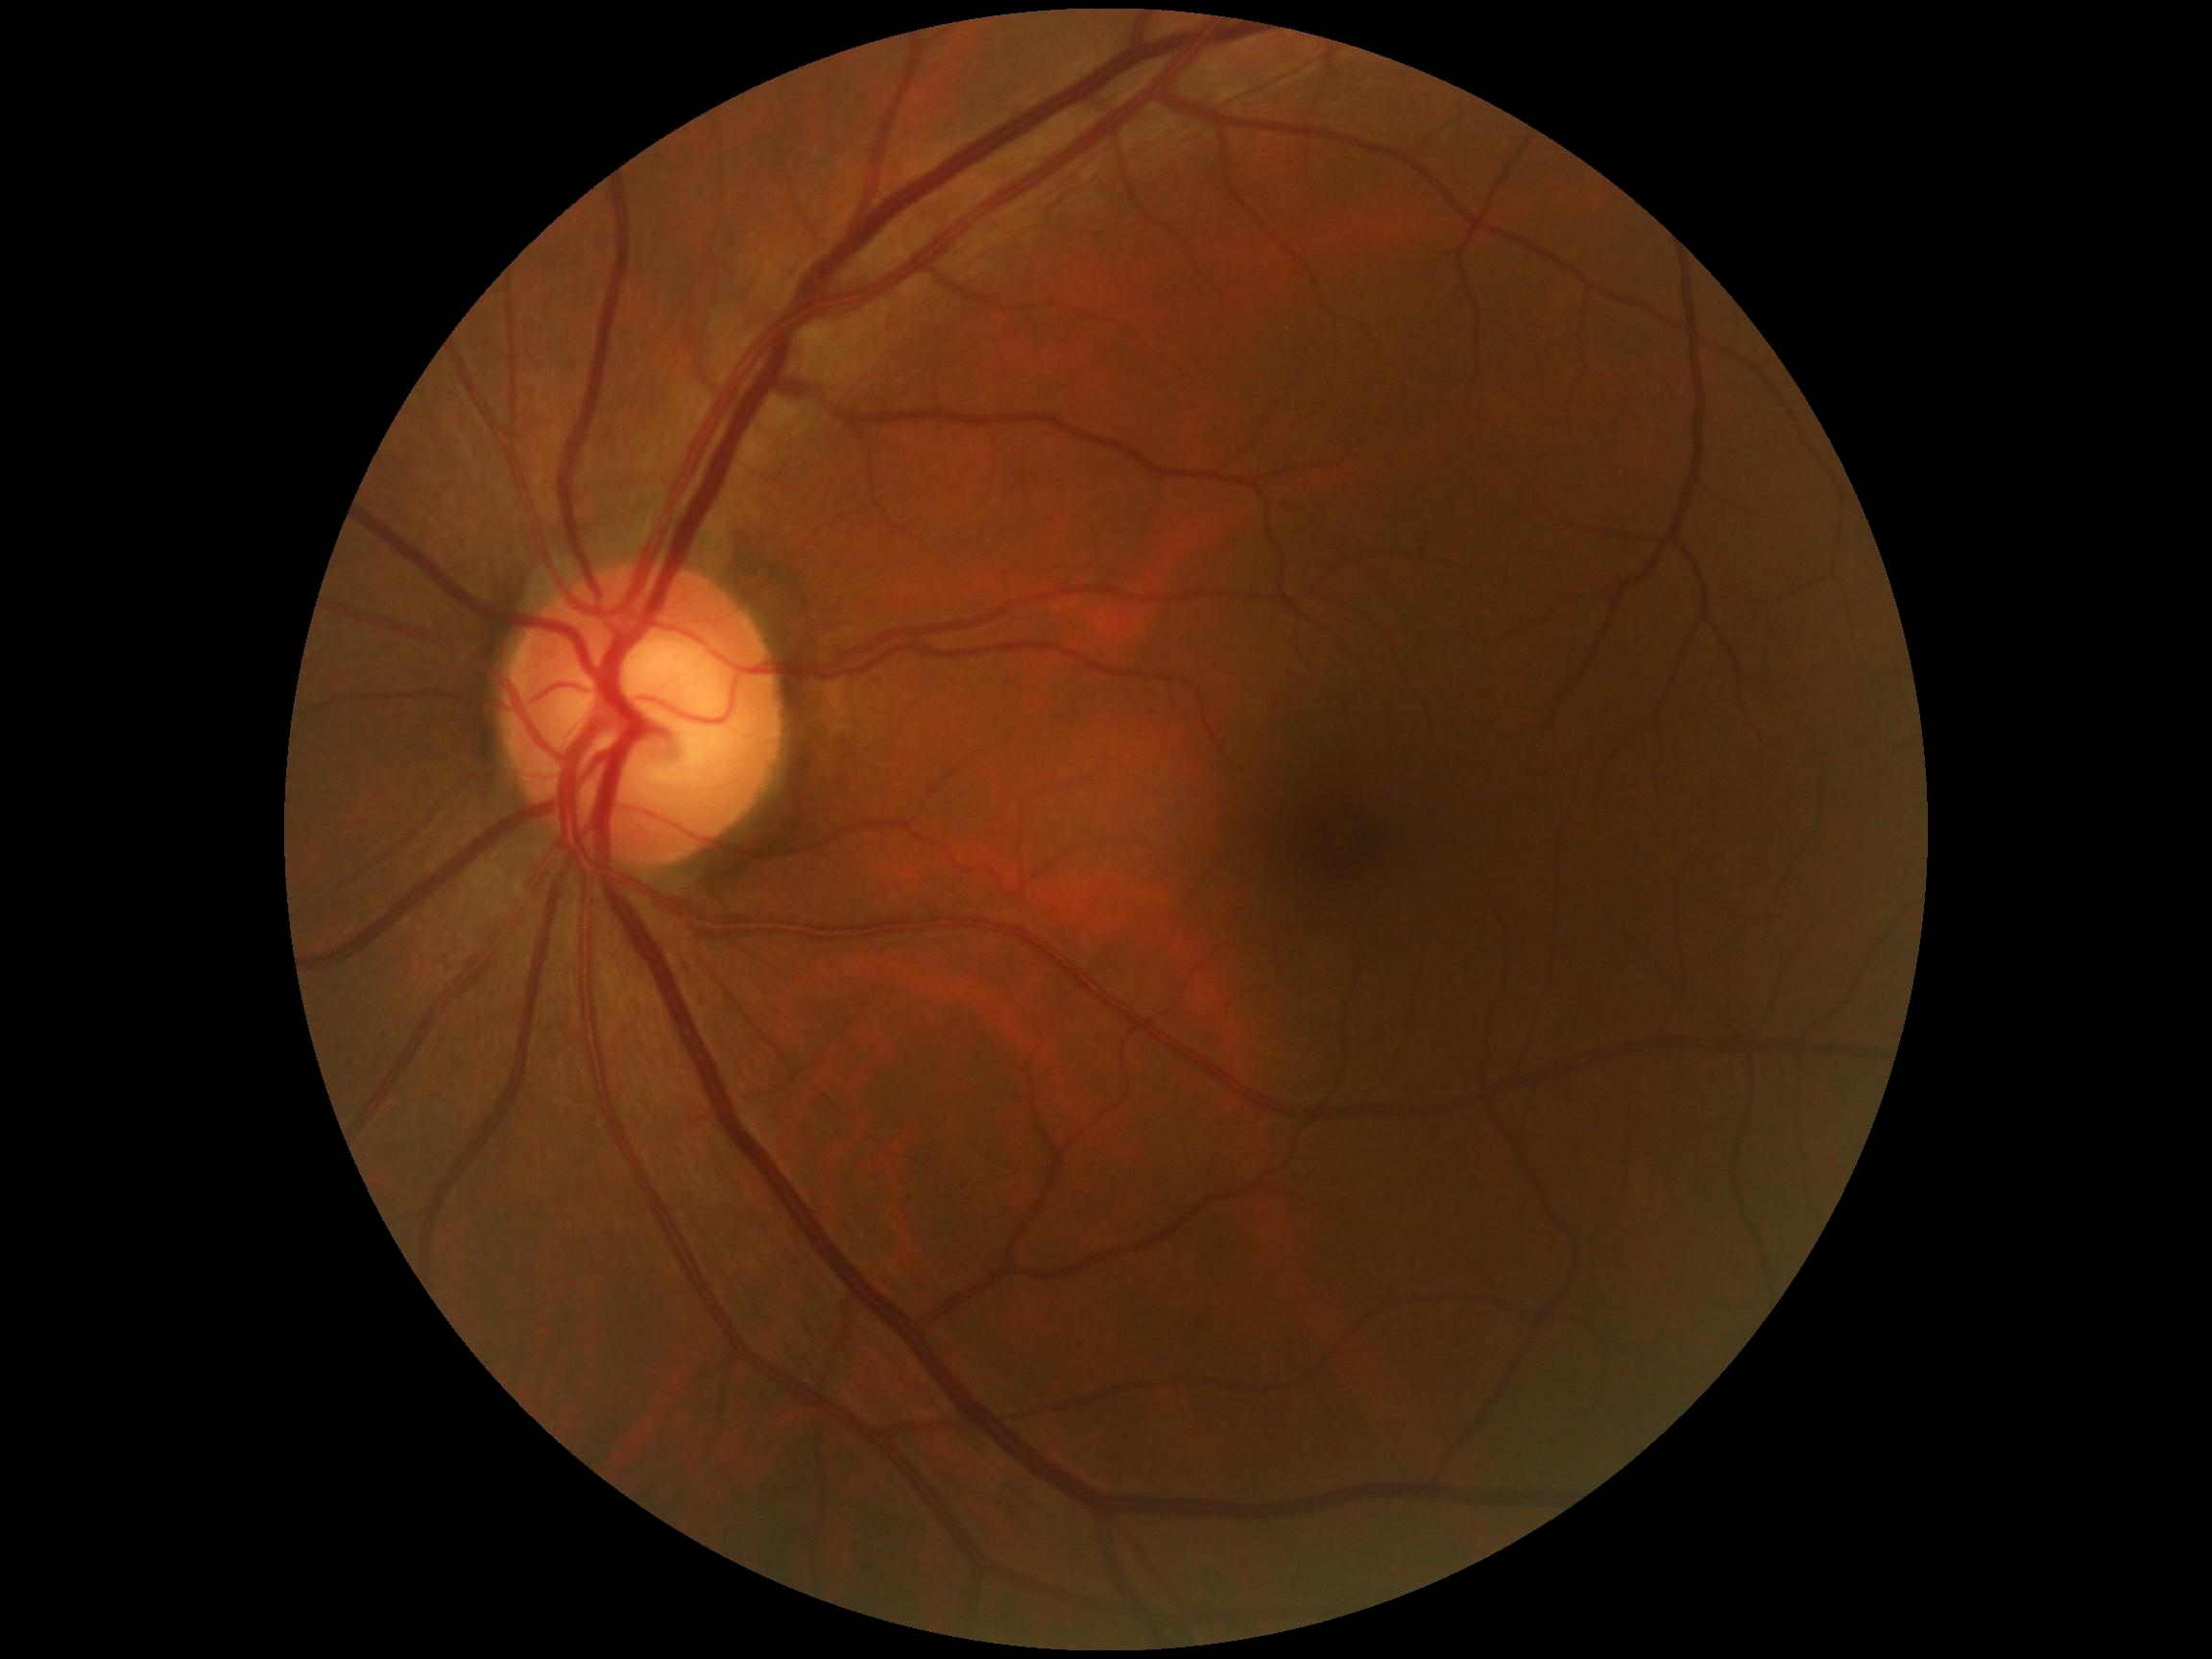

DR grade is 0/4.